Color fundus photograph, FOV: 45 degrees.
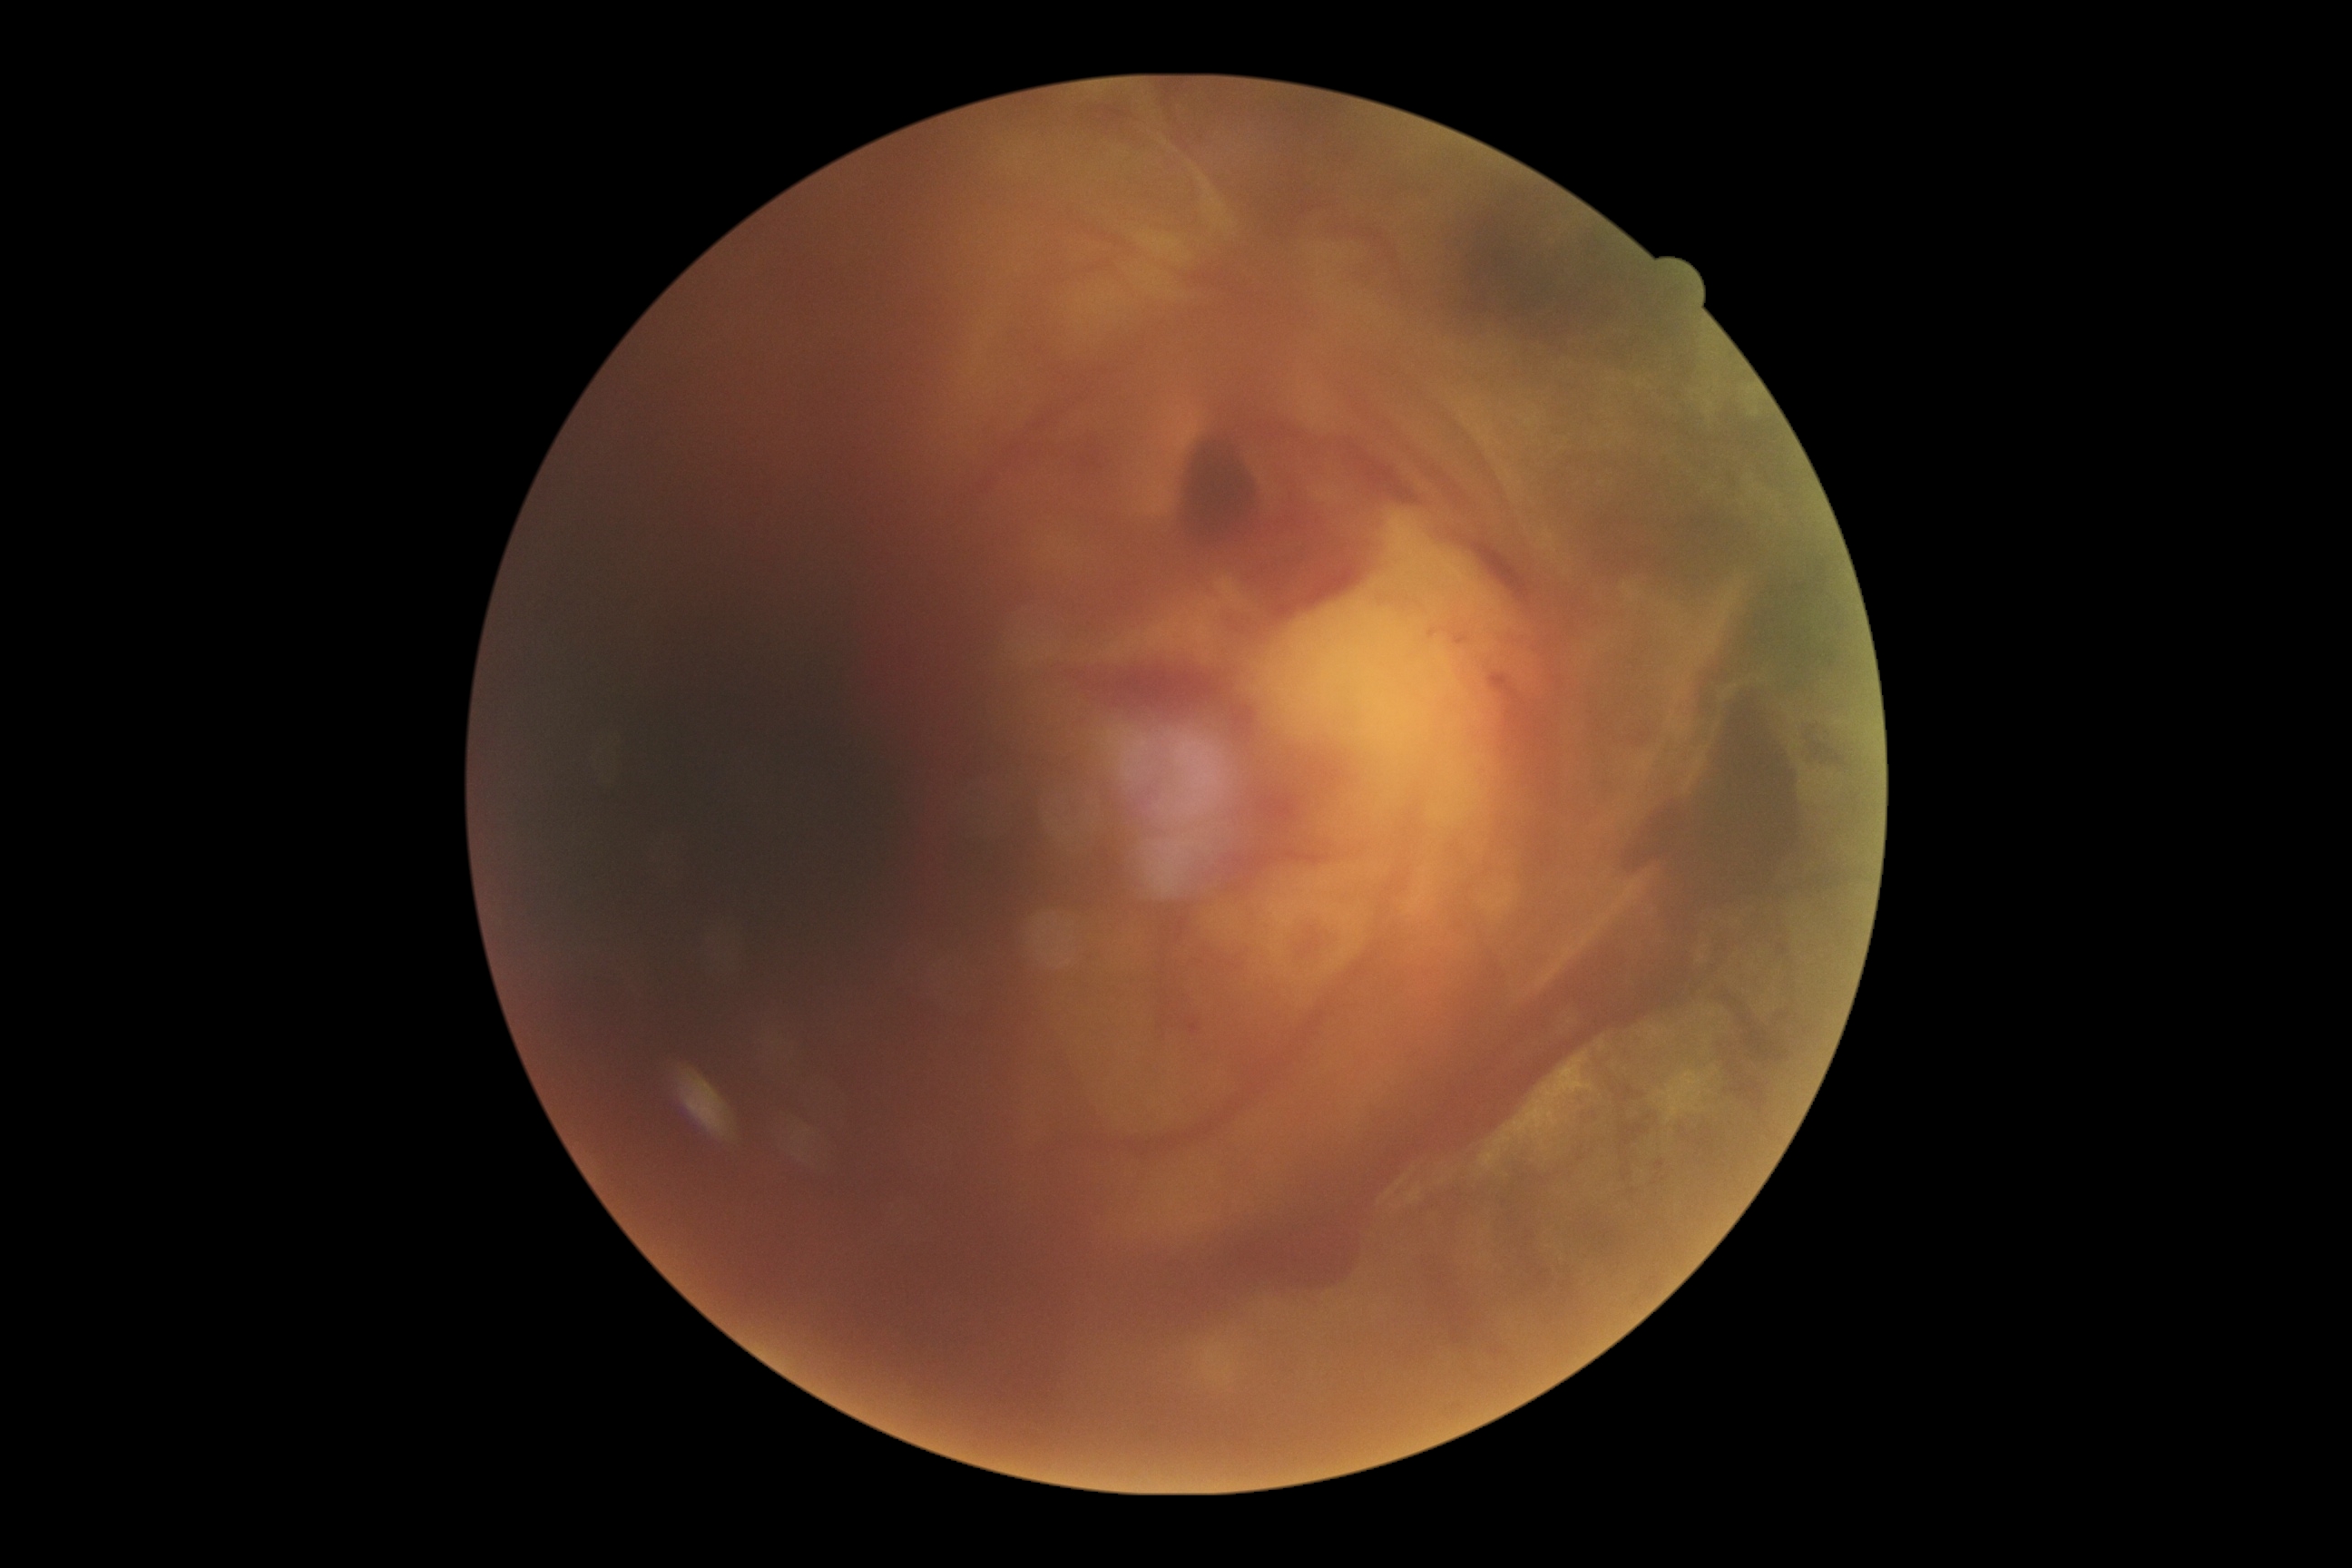
DR grade is proliferative diabetic retinopathy (4).